Acquired on the Clarity RetCam 3; image size 640x480; wide-field fundus photograph from neonatal ROP screening — 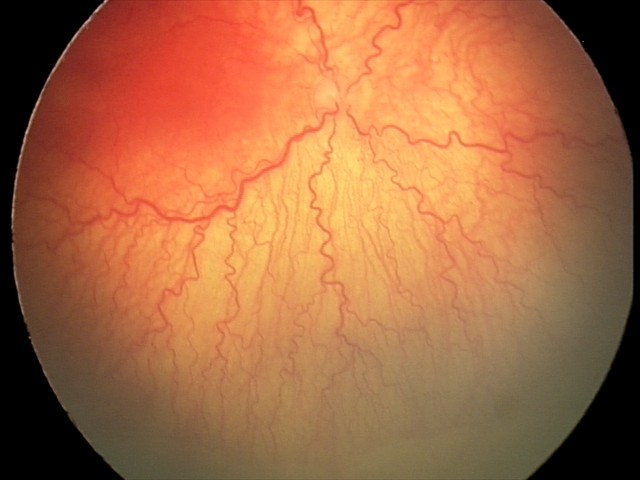
Plus disease present.
Screening series with aggressive ROP (A-ROP) — rapidly progressive severe ROP with prominent plus disease, often without classic stage progression.